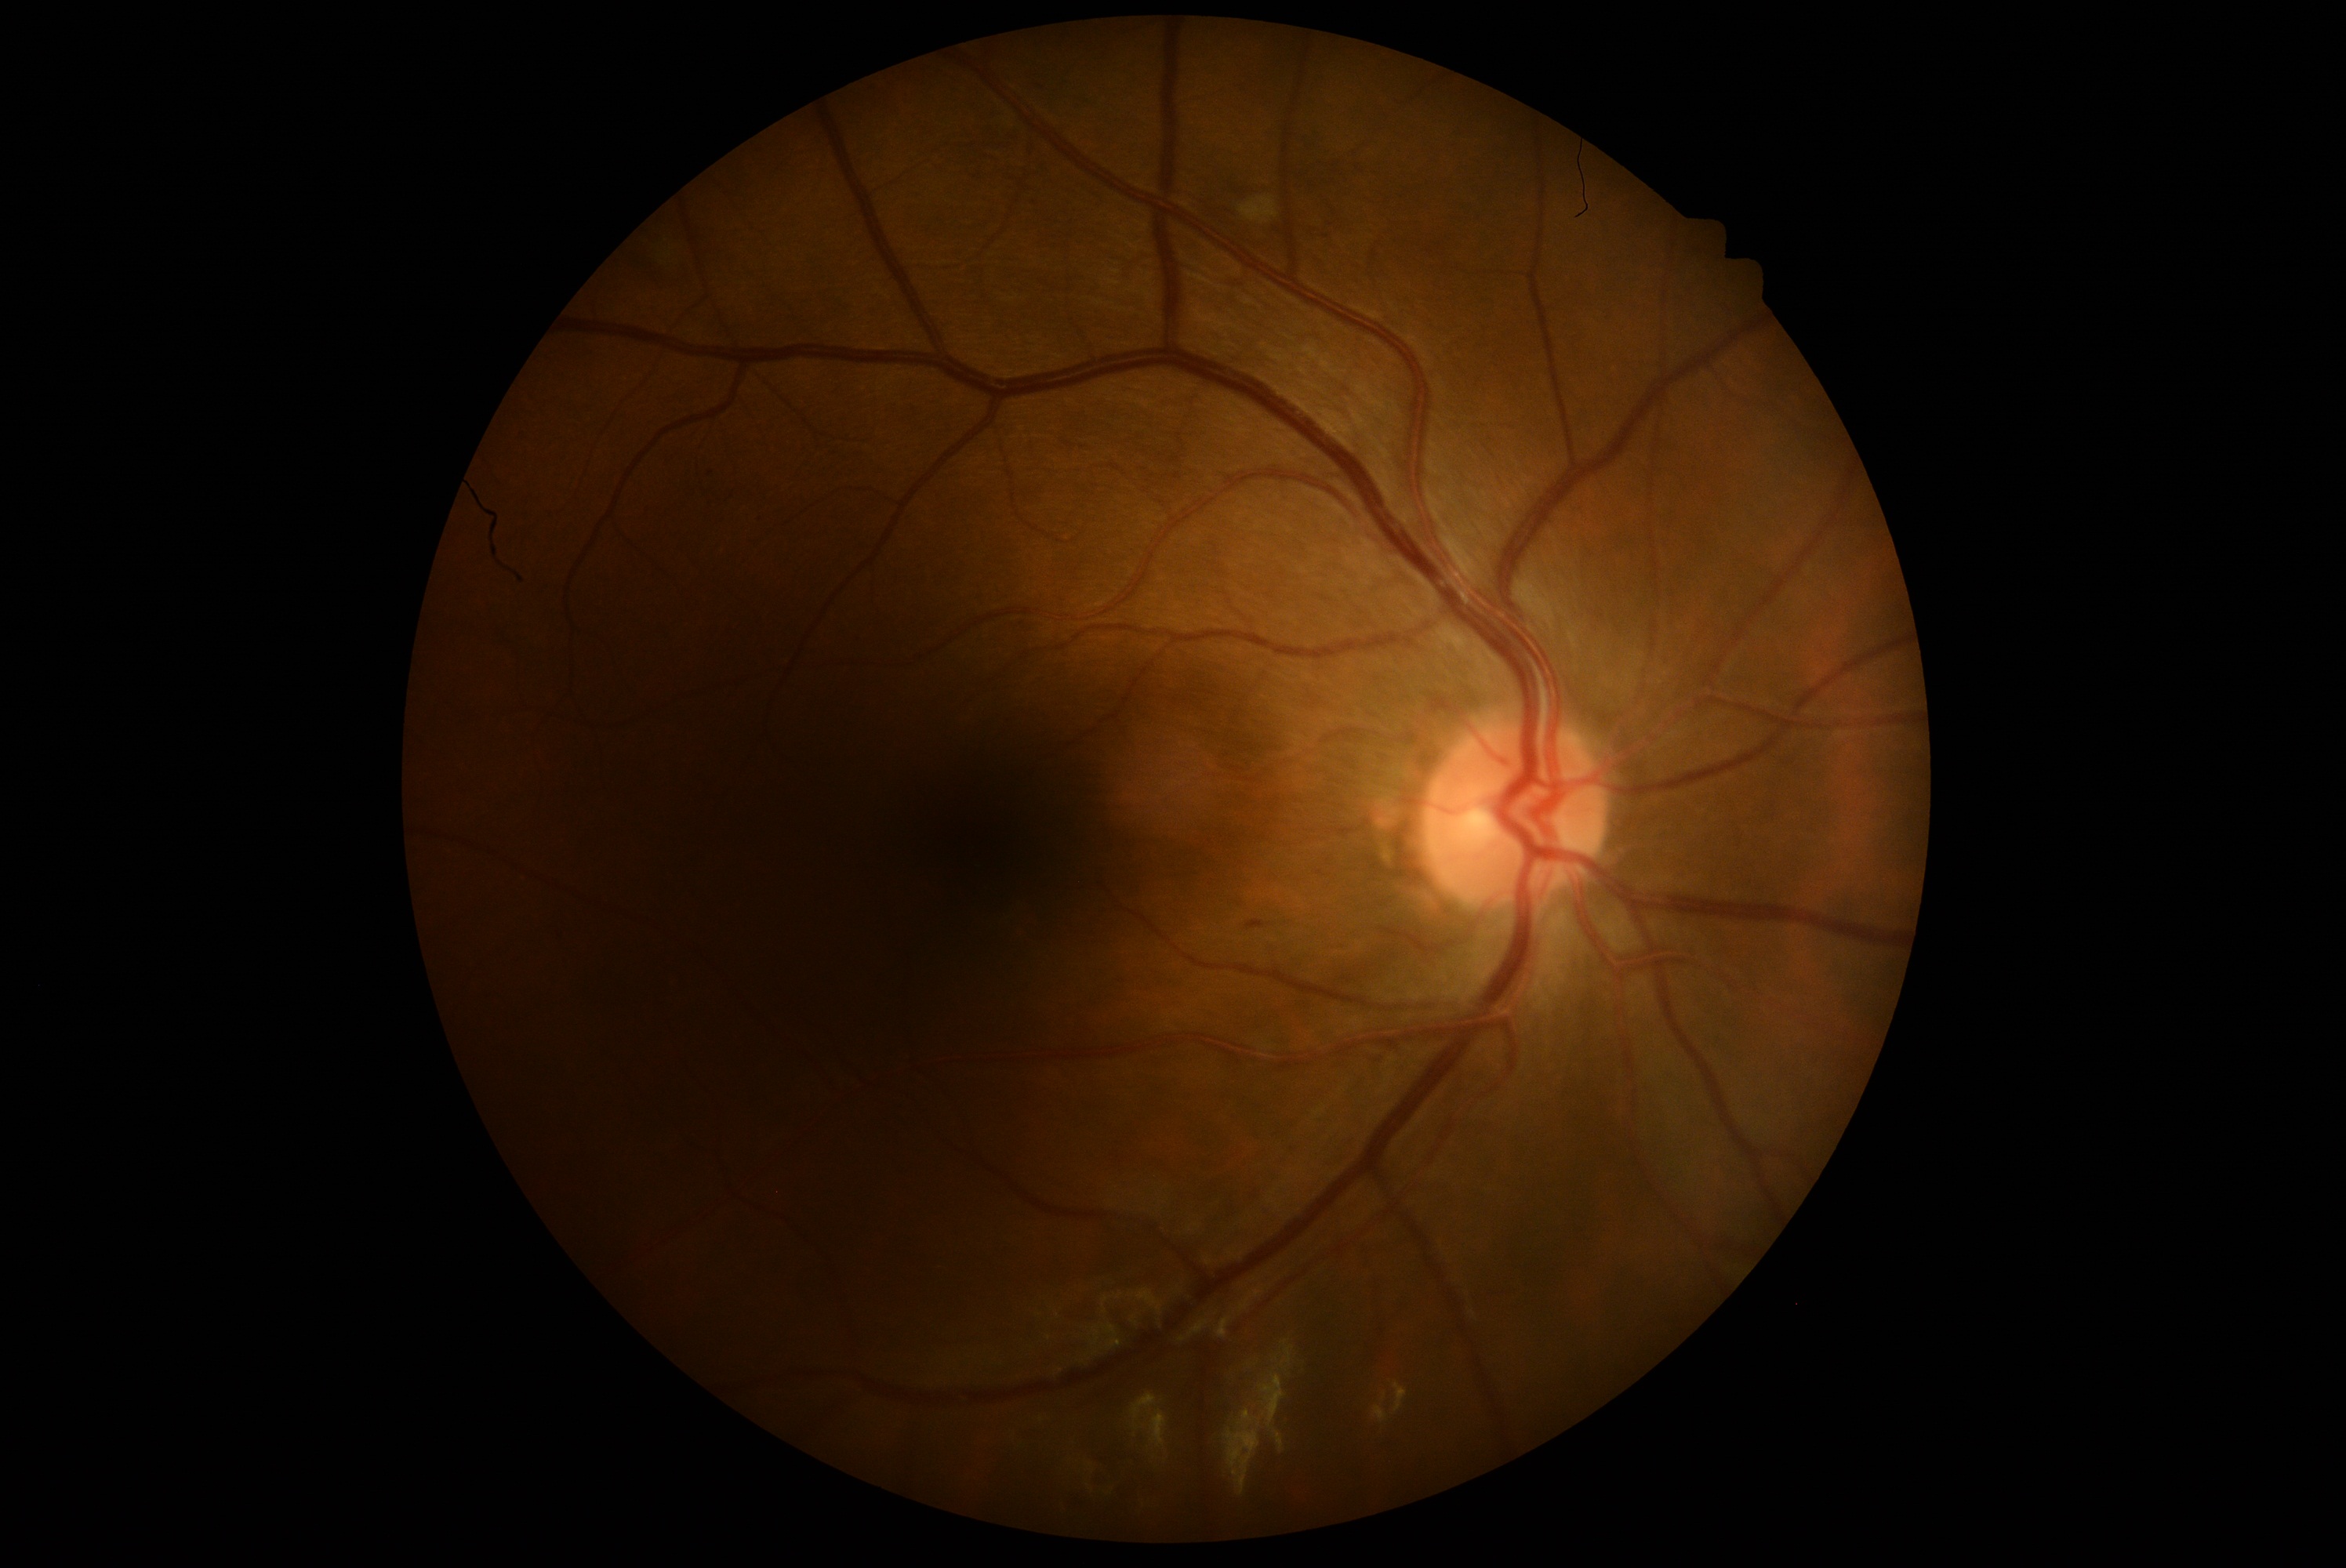
Diabetic retinopathy (DR): moderate NPDR (grade 2) — more than just microaneurysms but less than severe NPDR.